Cropped to the optic nerve head — 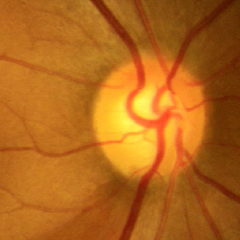 Q: Is glaucoma present?
A: Early glaucoma.